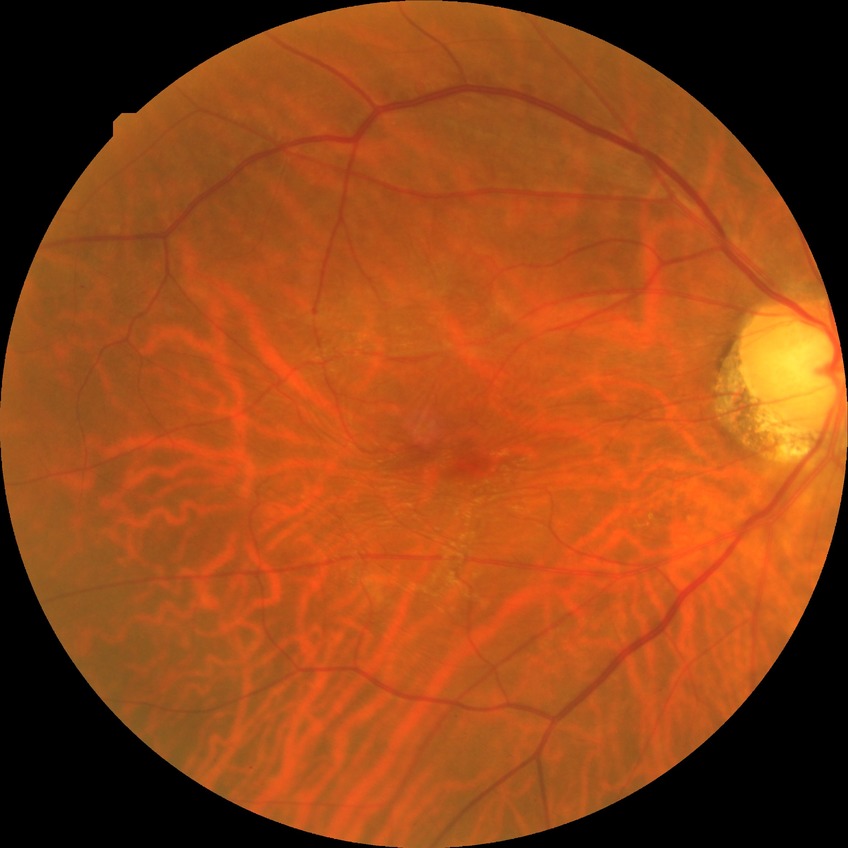
{"davis_grade": "no diabetic retinopathy (NDR)"}